Nonmydriatic fundus photograph. Image size 848x848.
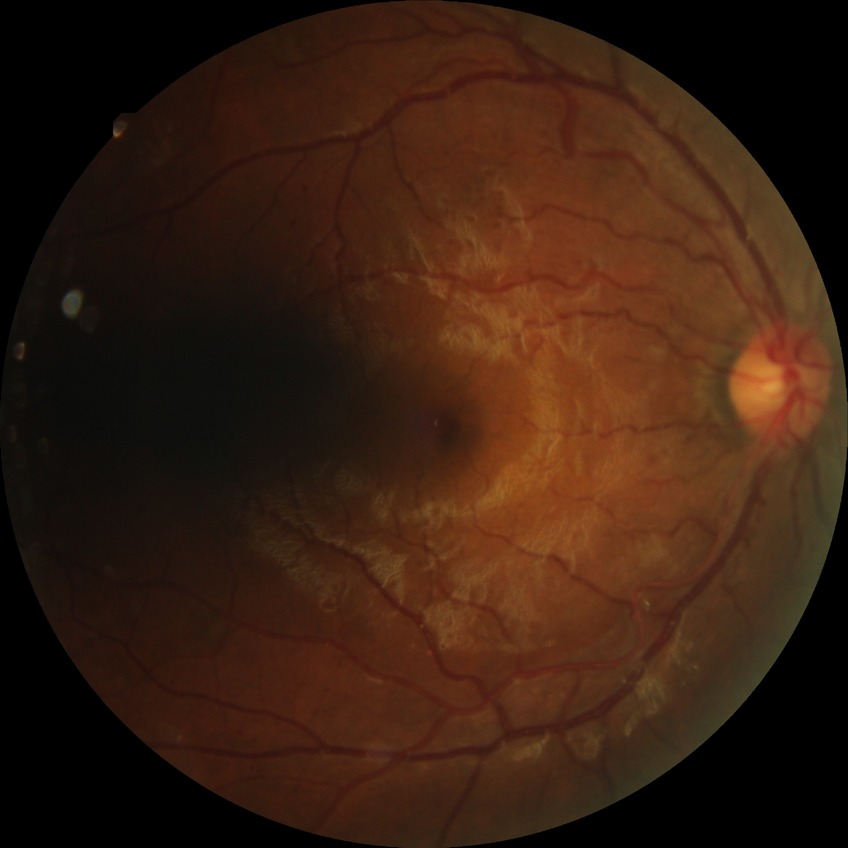 • diabetic retinopathy (DR) — PPDR (pre-proliferative diabetic retinopathy)